45° FOV:
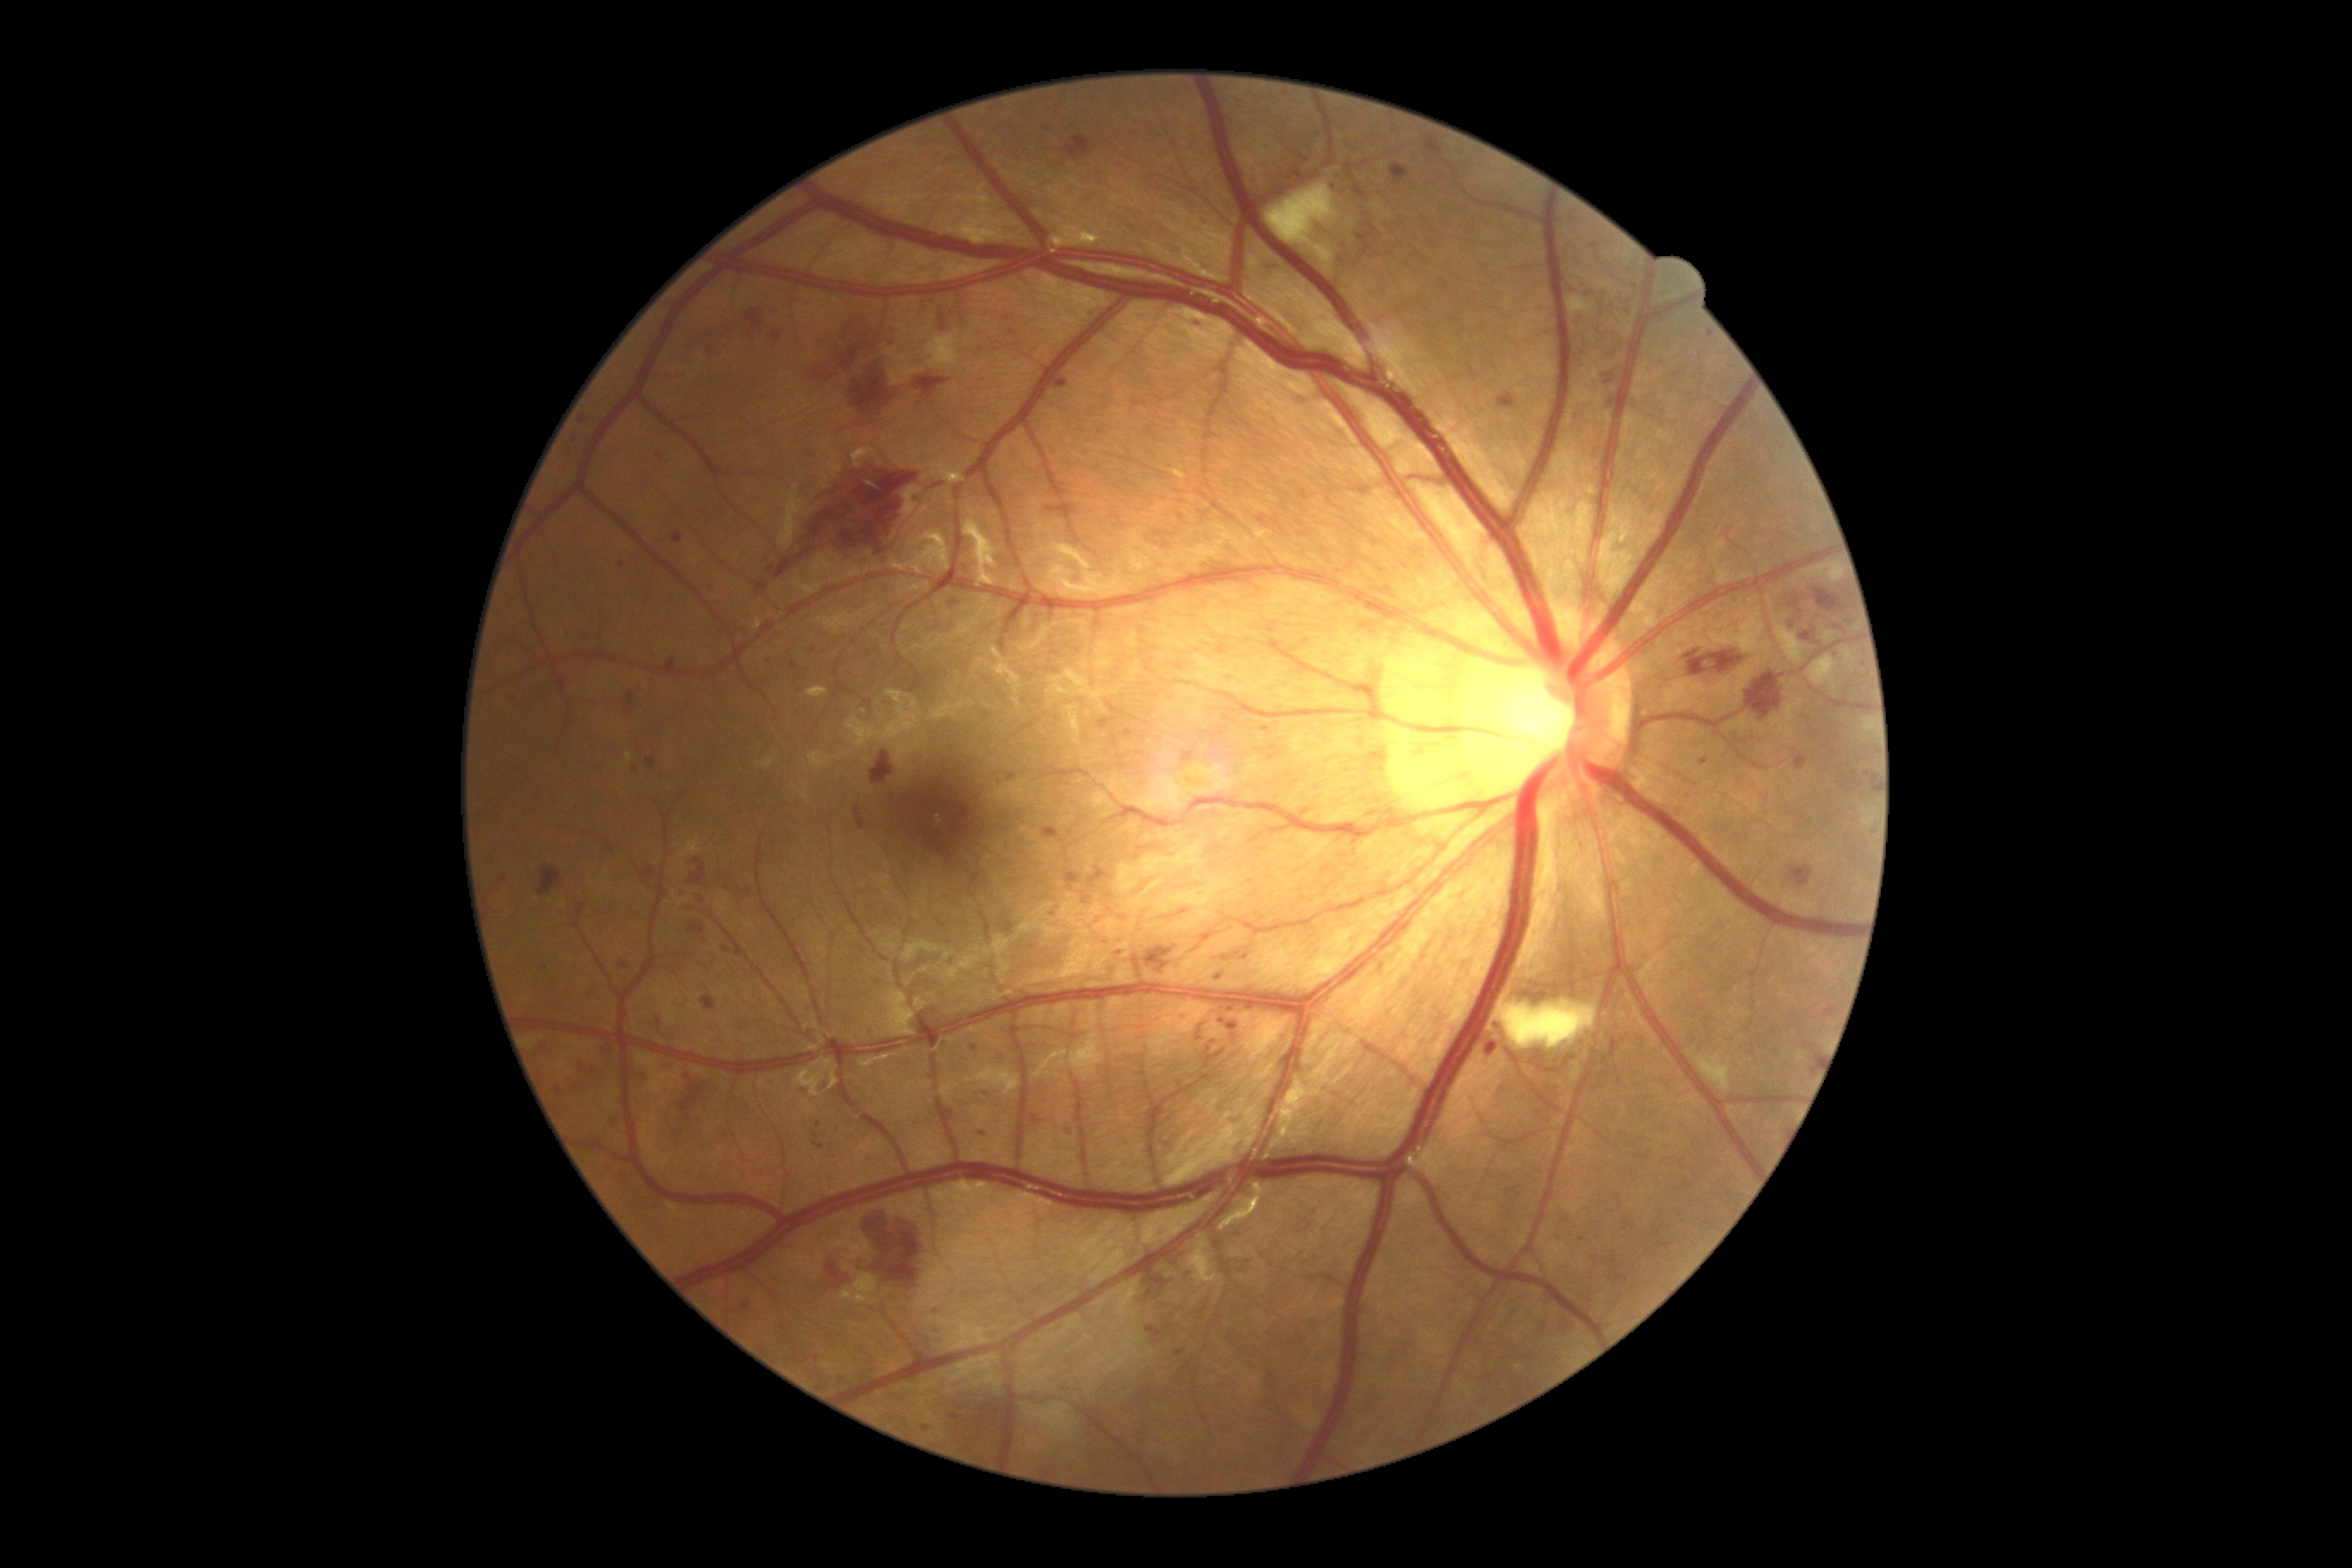
Diabetic retinopathy (DR) is grade 3 (severe NPDR)
Representative lesions:
hemorrhages (HEs) (more not shown): rect(1746, 671, 1784, 720); rect(1144, 948, 1173, 974); rect(838, 350, 857, 371); rect(1099, 718, 1117, 730); rect(603, 1048, 613, 1053); rect(646, 756, 656, 771); rect(1873, 778, 1877, 792); rect(1497, 395, 1517, 410); rect(1791, 866, 1815, 886); rect(656, 1015, 666, 1032); rect(689, 922, 706, 936); rect(640, 867, 656, 885); rect(1065, 135, 1094, 157); rect(830, 1259, 859, 1292); rect(890, 336, 897, 350); rect(1182, 752, 1194, 763); rect(940, 315, 948, 333); rect(556, 1087, 563, 1096)
HEs (small, approximate centers) near (x=636, y=768)